45-degree field of view:
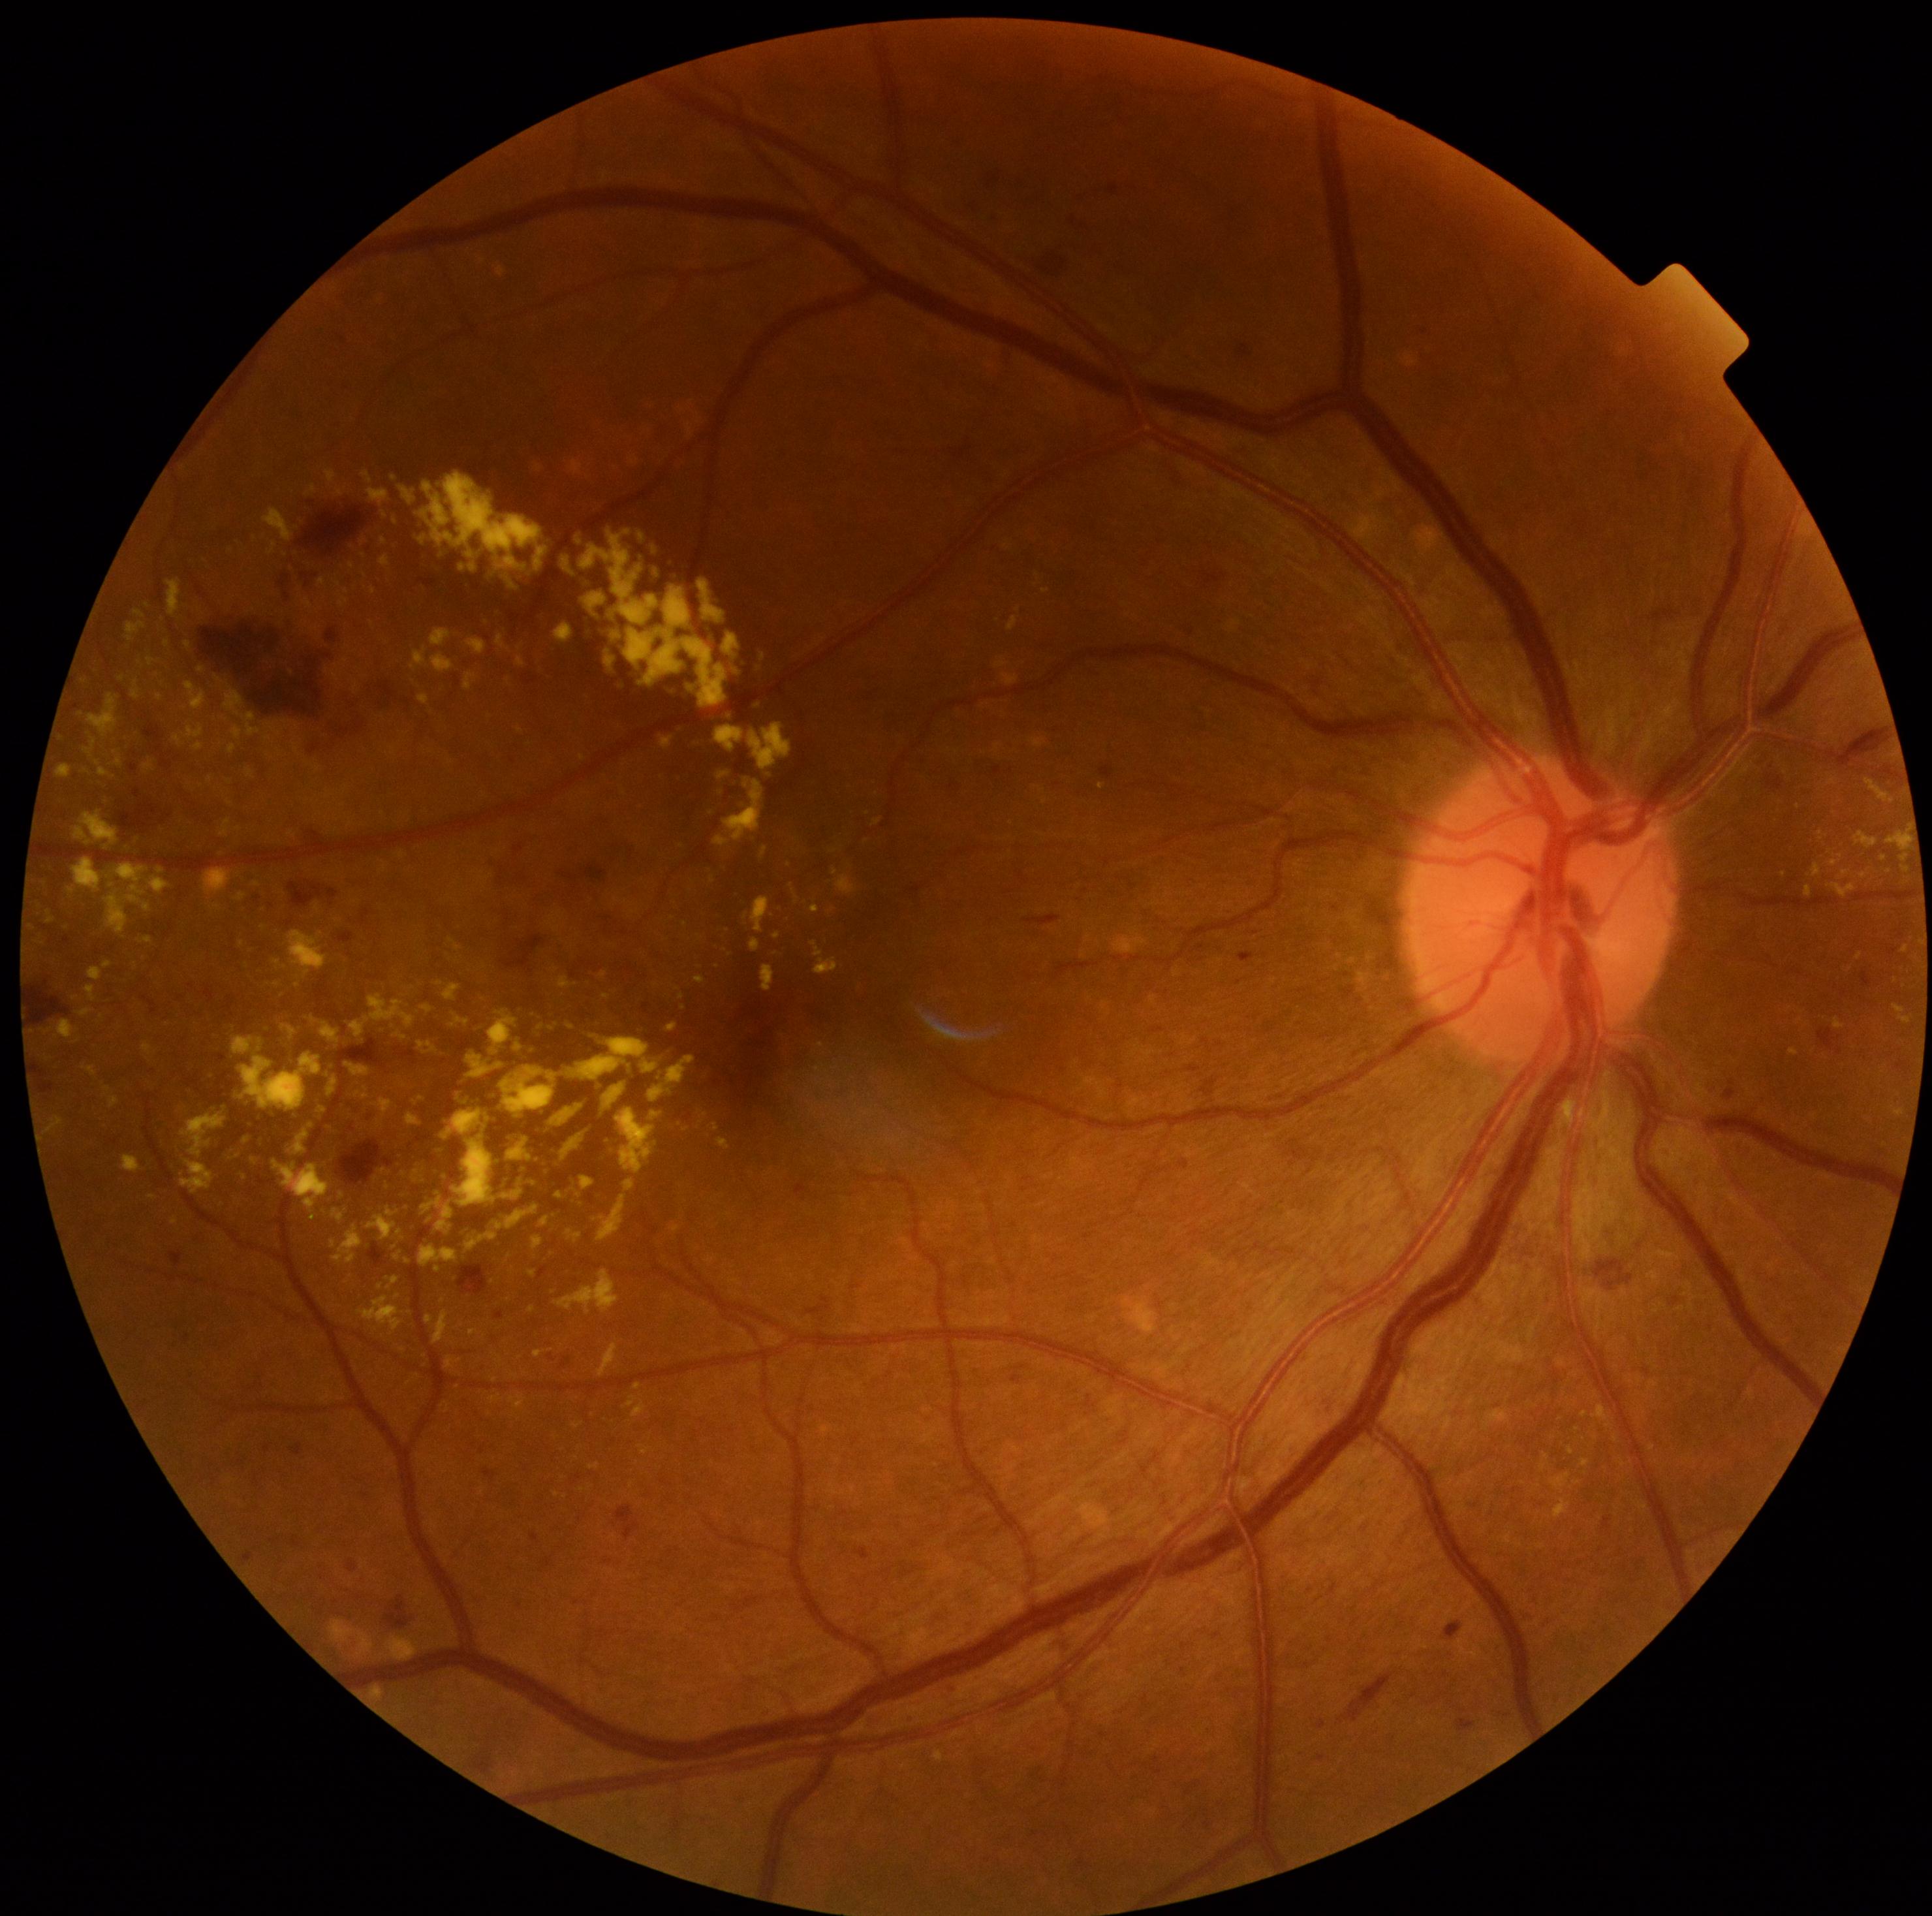 DR severity: grade 2 (moderate NPDR)
Representative lesions:
EXs (subset): [1595, 1405, 1609, 1422], [434, 1310, 450, 1343], [582, 531, 660, 628], [687, 685, 698, 693], [717, 772, 730, 781], [430, 629, 451, 646], [1581, 1410, 1589, 1417], [660, 736, 673, 751], [264, 734, 272, 742], [563, 559, 572, 574], [104, 1086, 112, 1098], [1581, 1460, 1591, 1466], [334, 1226, 364, 1264]
Additional small EXs near (278, 984), (346, 591), (350, 824), (1906, 870), (374, 591), (1624, 1463), (403, 1085)